100° field of view (Phoenix ICON) · infant wide-field fundus photograph: 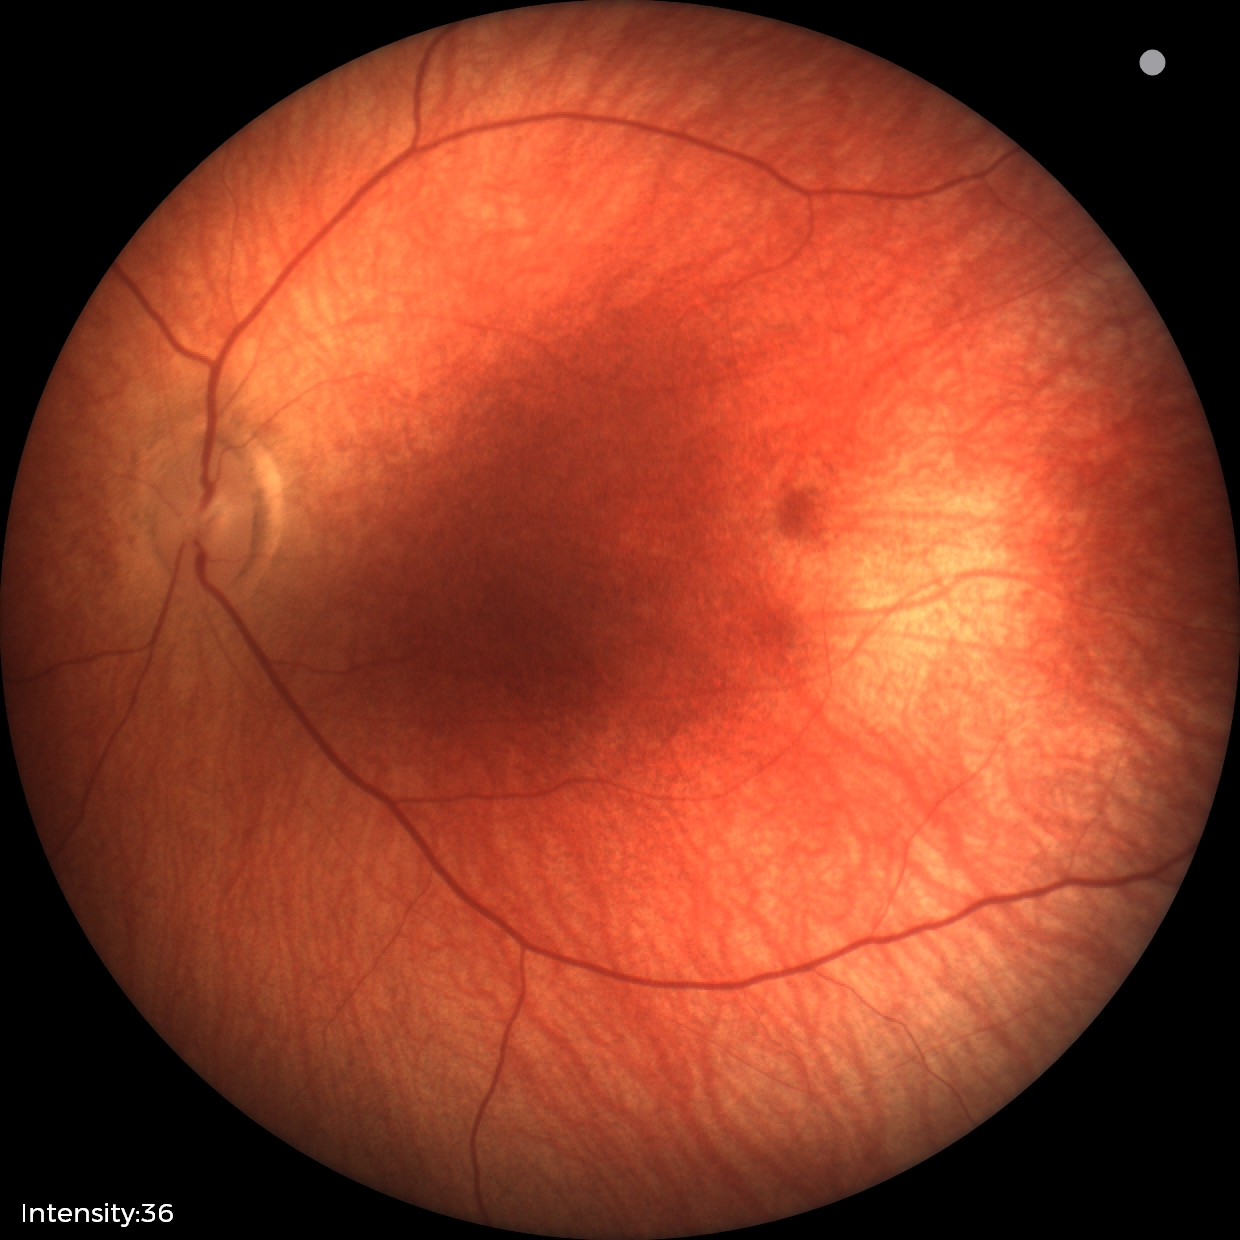

Assessment: normal.